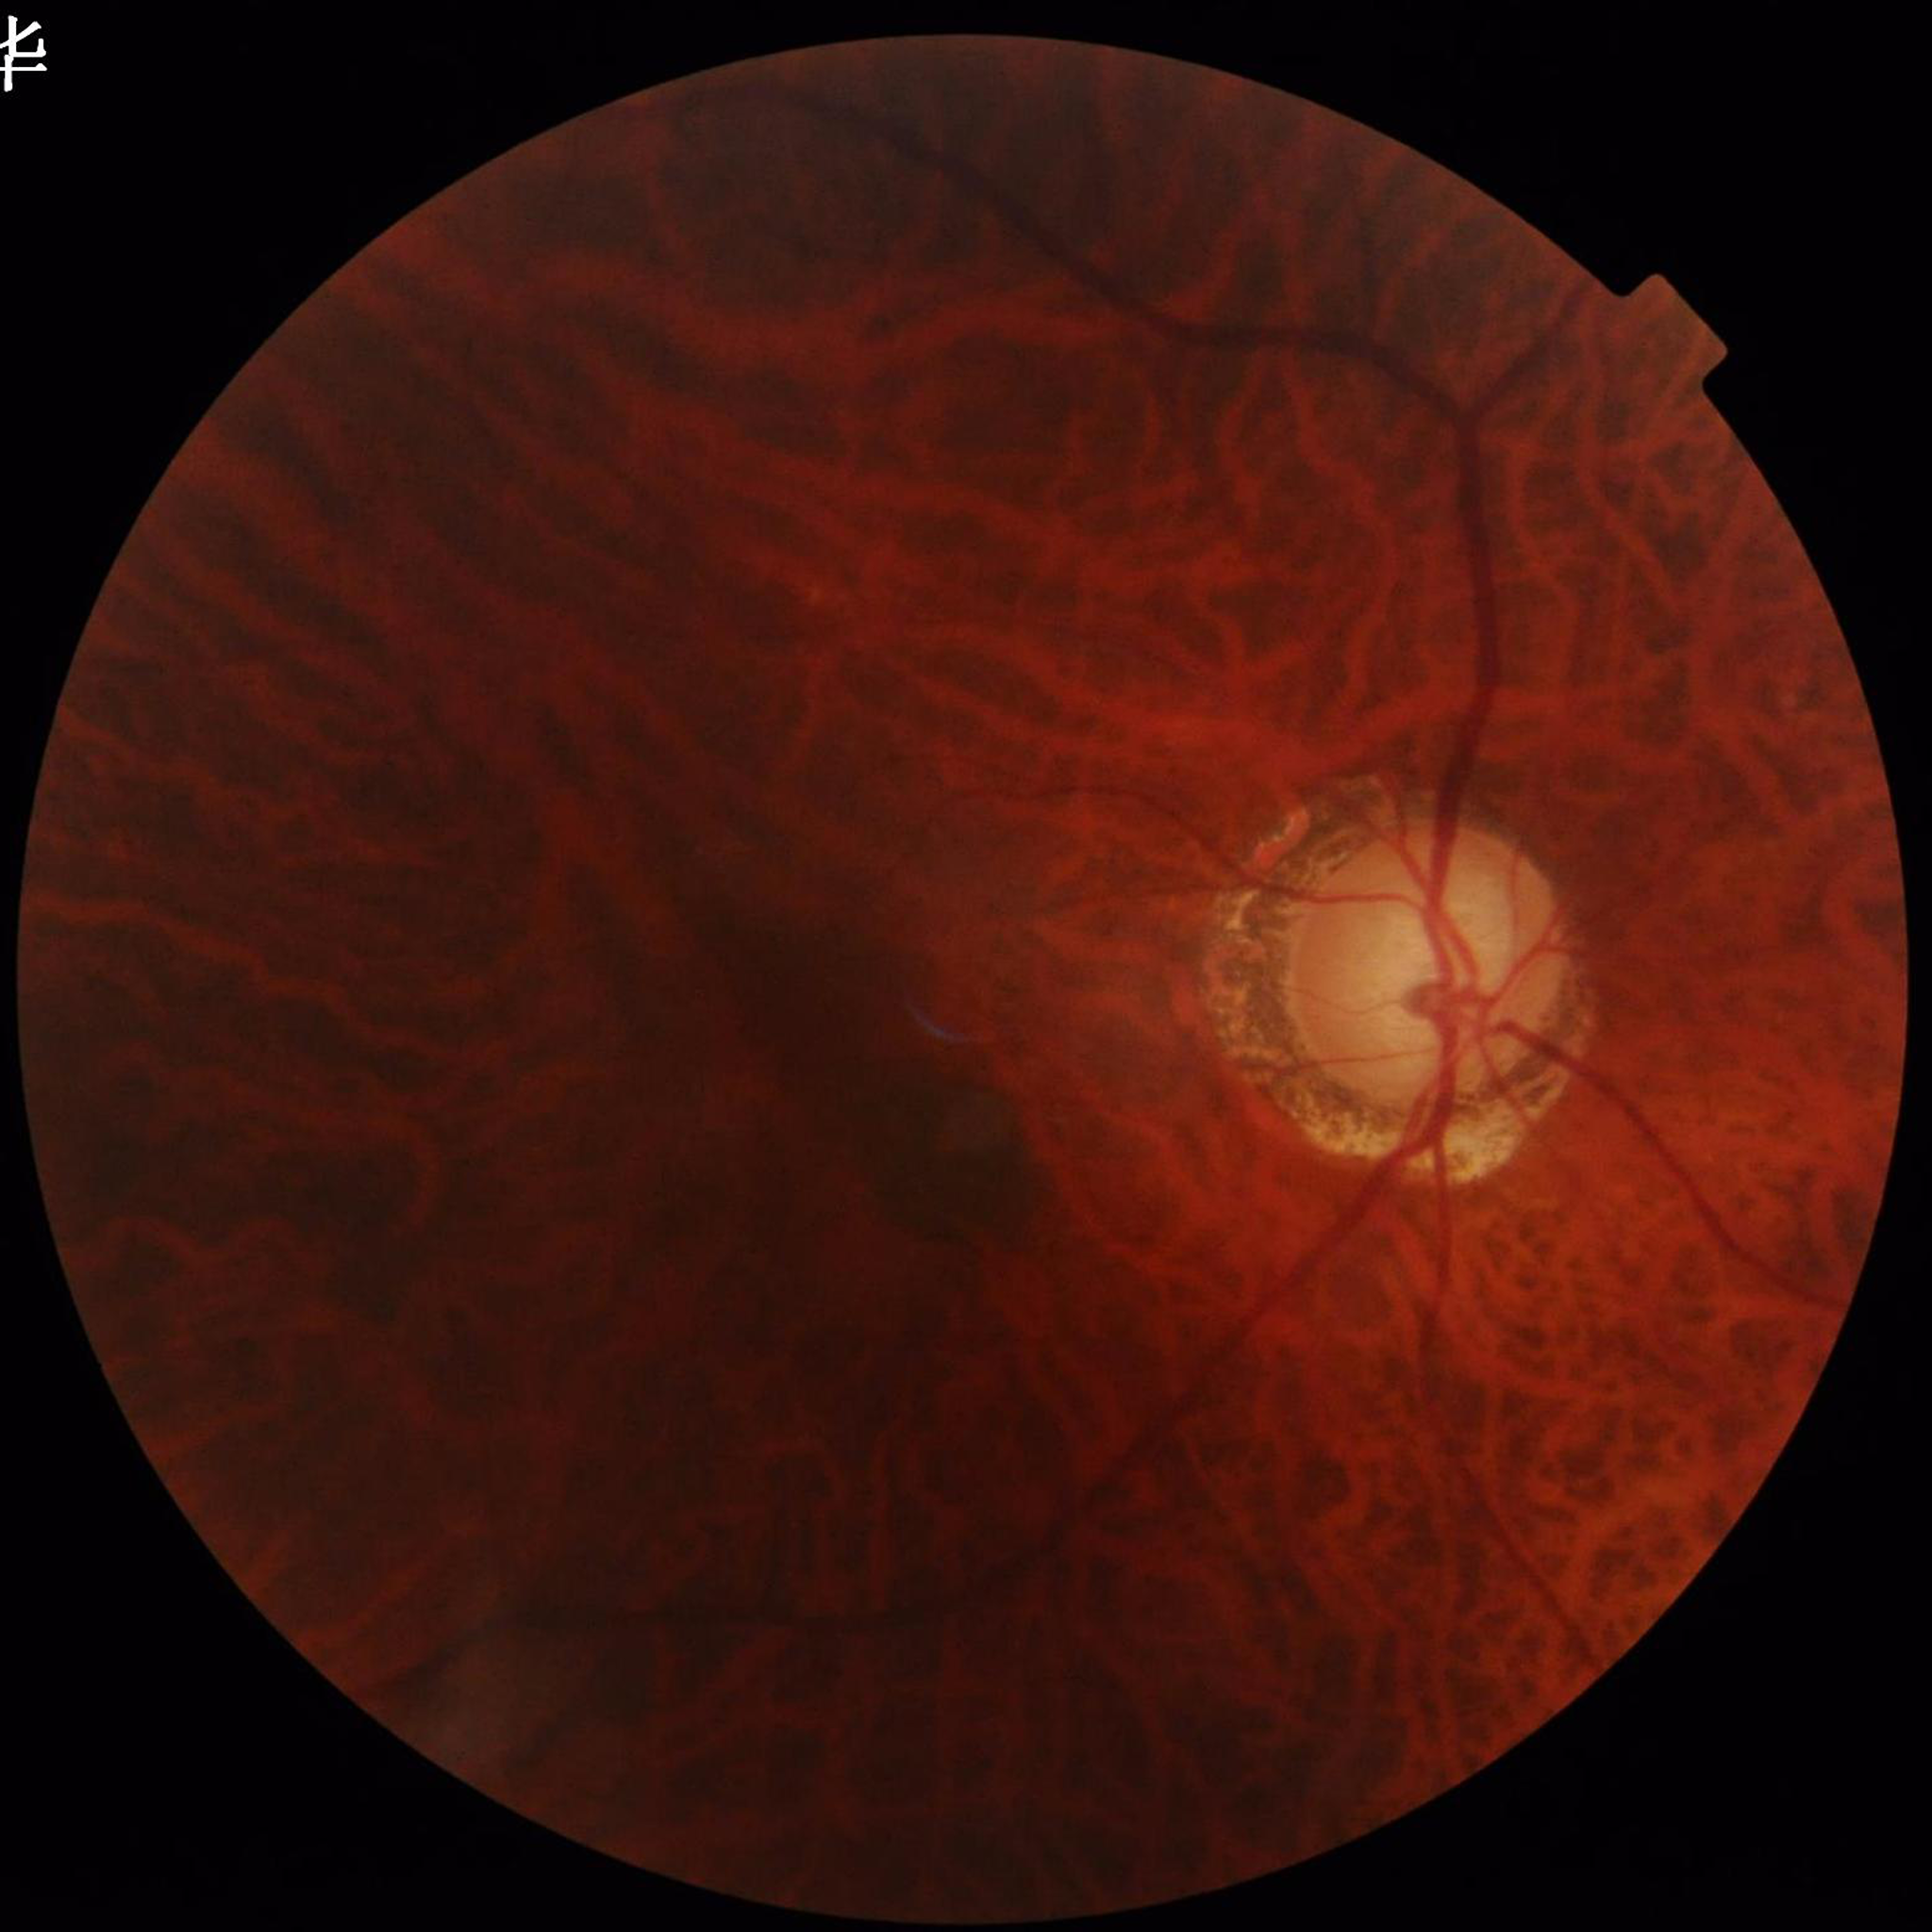
Quality assessment: blur present, contrast adequate, illumination/color distortion present; Disease class: glaucoma.